848x848. Without pupil dilation. Graded on the modified Davis scale: 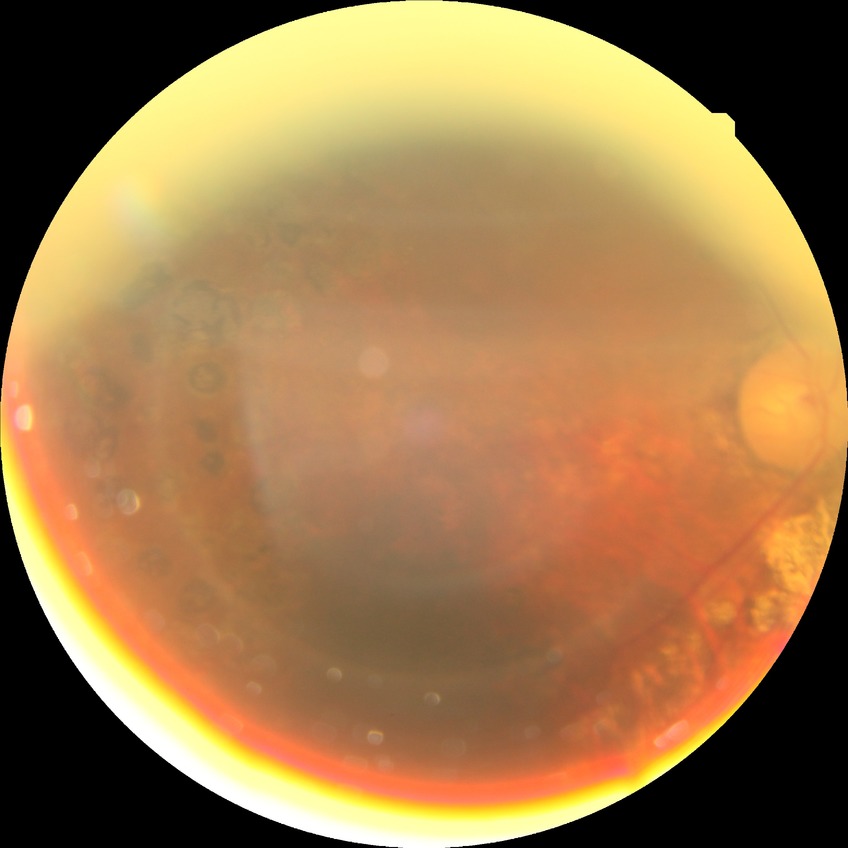

modified Davis grading = proliferative diabetic retinopathy.